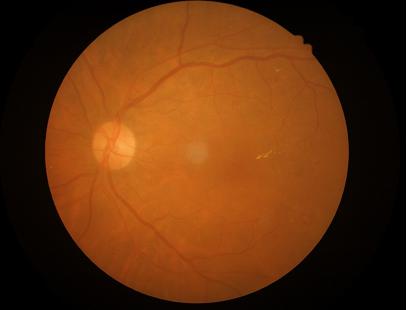
Contrast is good.
Illumination is even.
Overall image quality is good.
The image is clear.